Retinal fundus photograph, 848 x 848 pixels, camera: NIDEK AFC-230
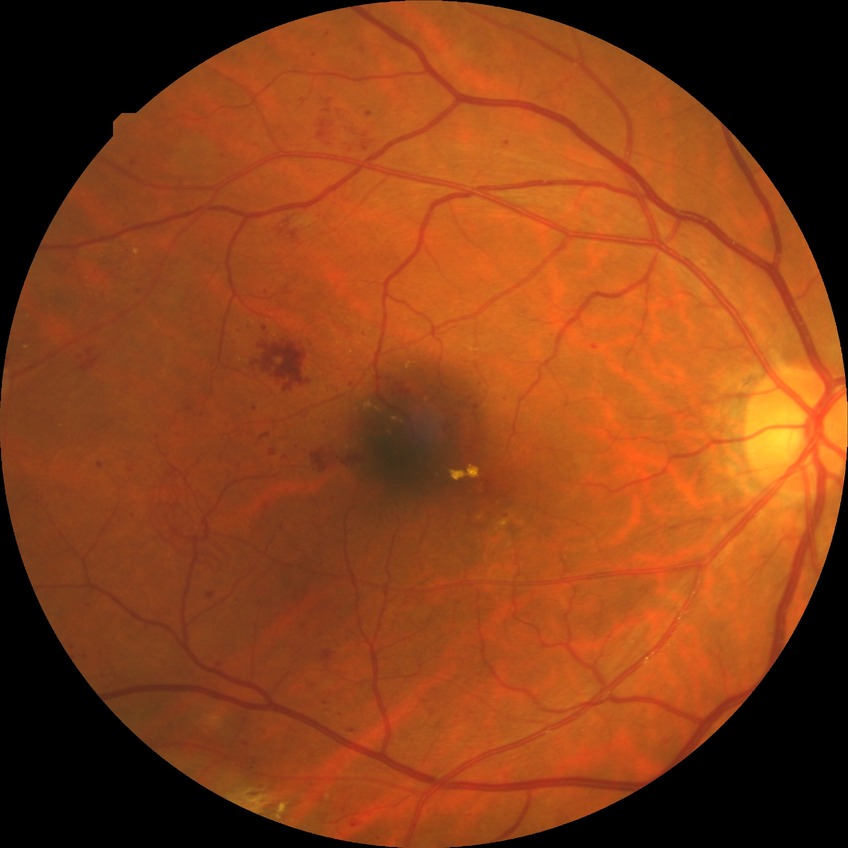

Retinopathy stage is proliferative diabetic retinopathy.